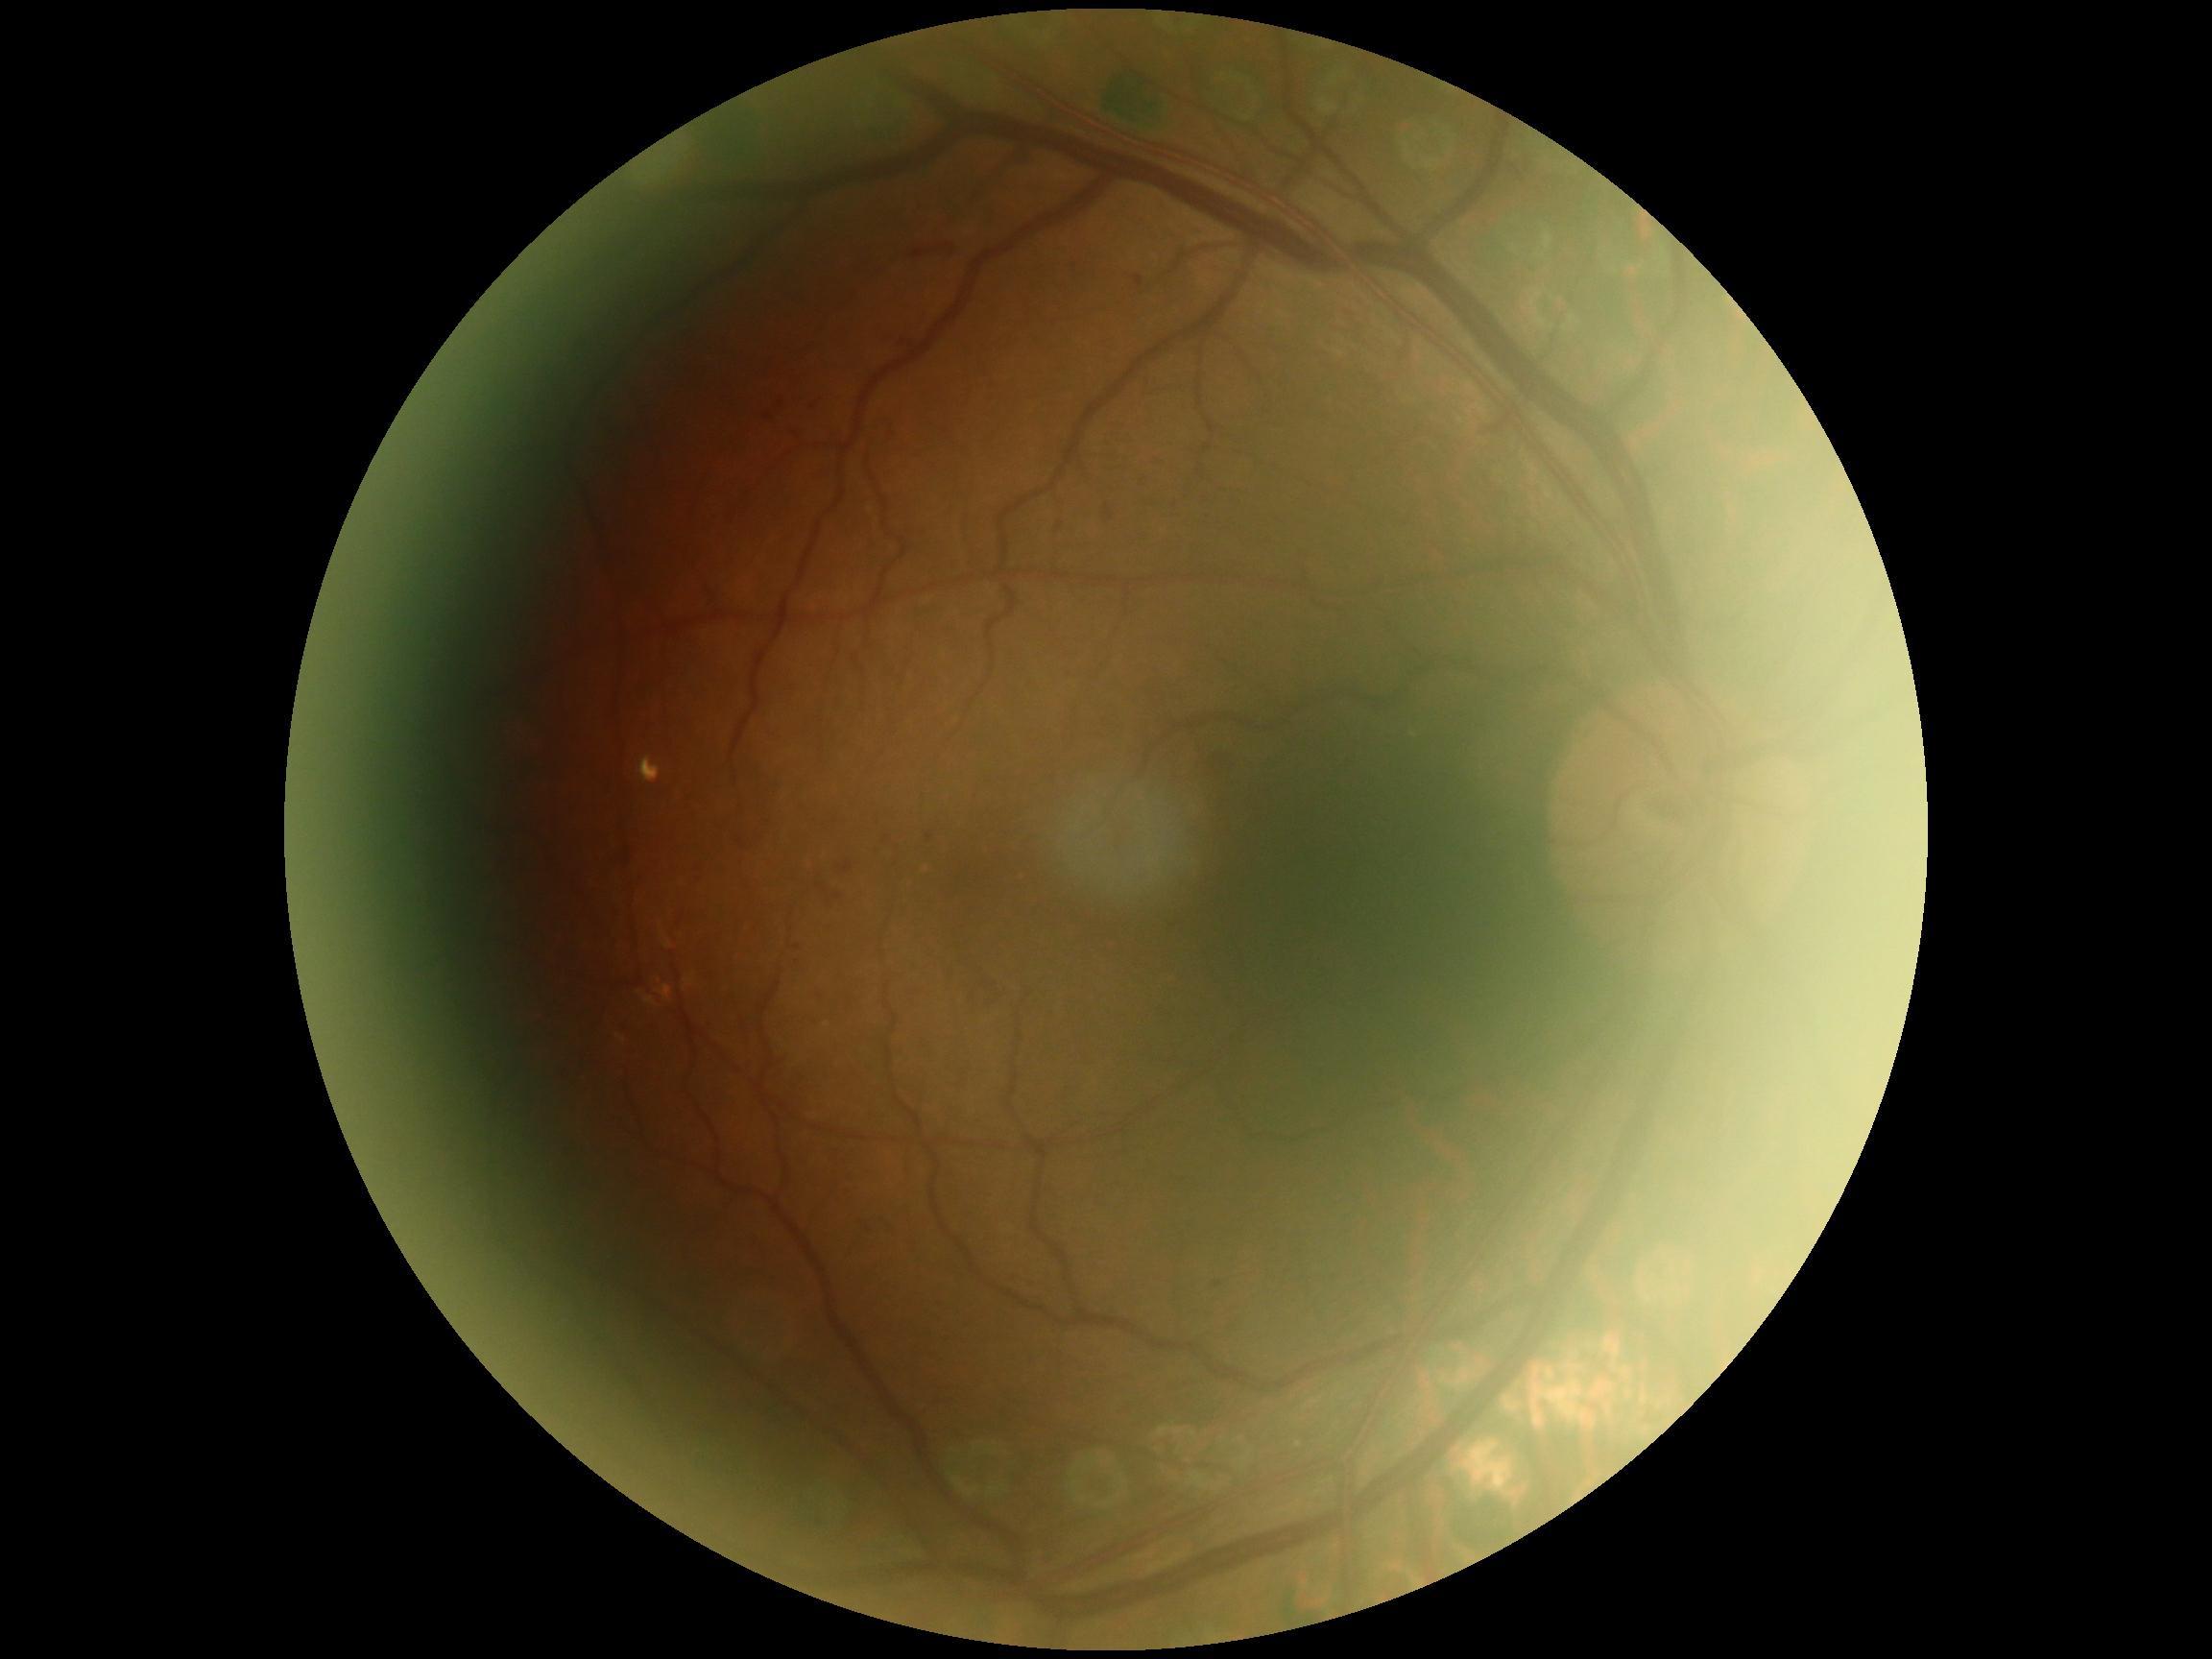 Annotations:
– DR class — non-proliferative diabetic retinopathy
– diabetic retinopathy (DR) — 2/4